Fundus photo · diabetic retinopathy graded by the modified Davis classification · 848x848:
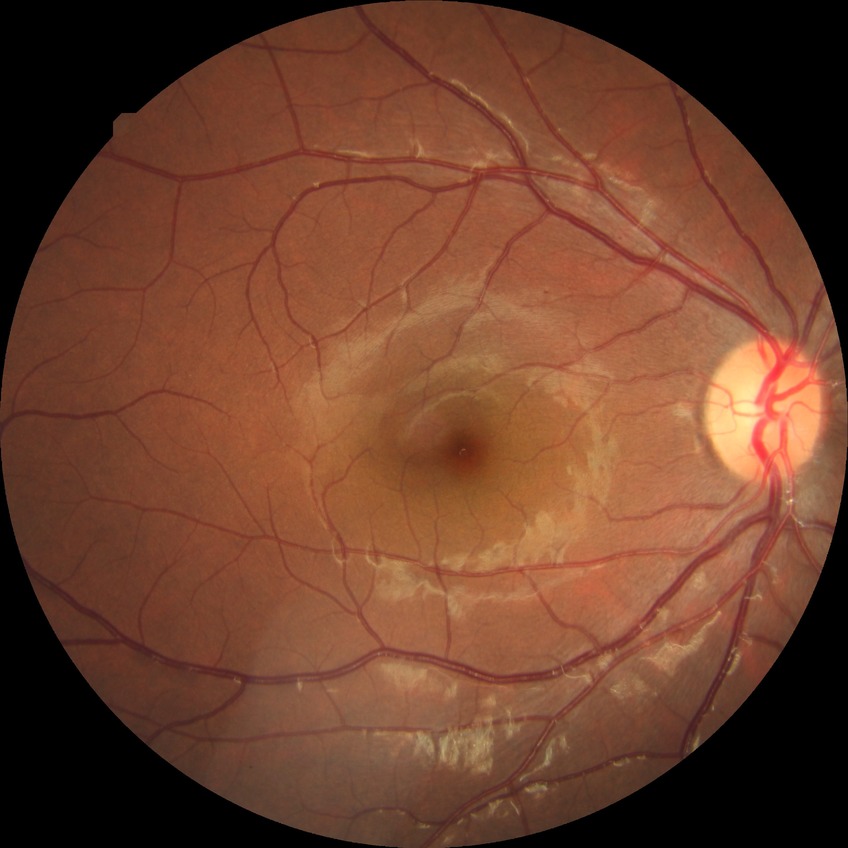 The retinopathy is classified as non-proliferative diabetic retinopathy. Davis stage: SDR.